Image size 2212x1659: 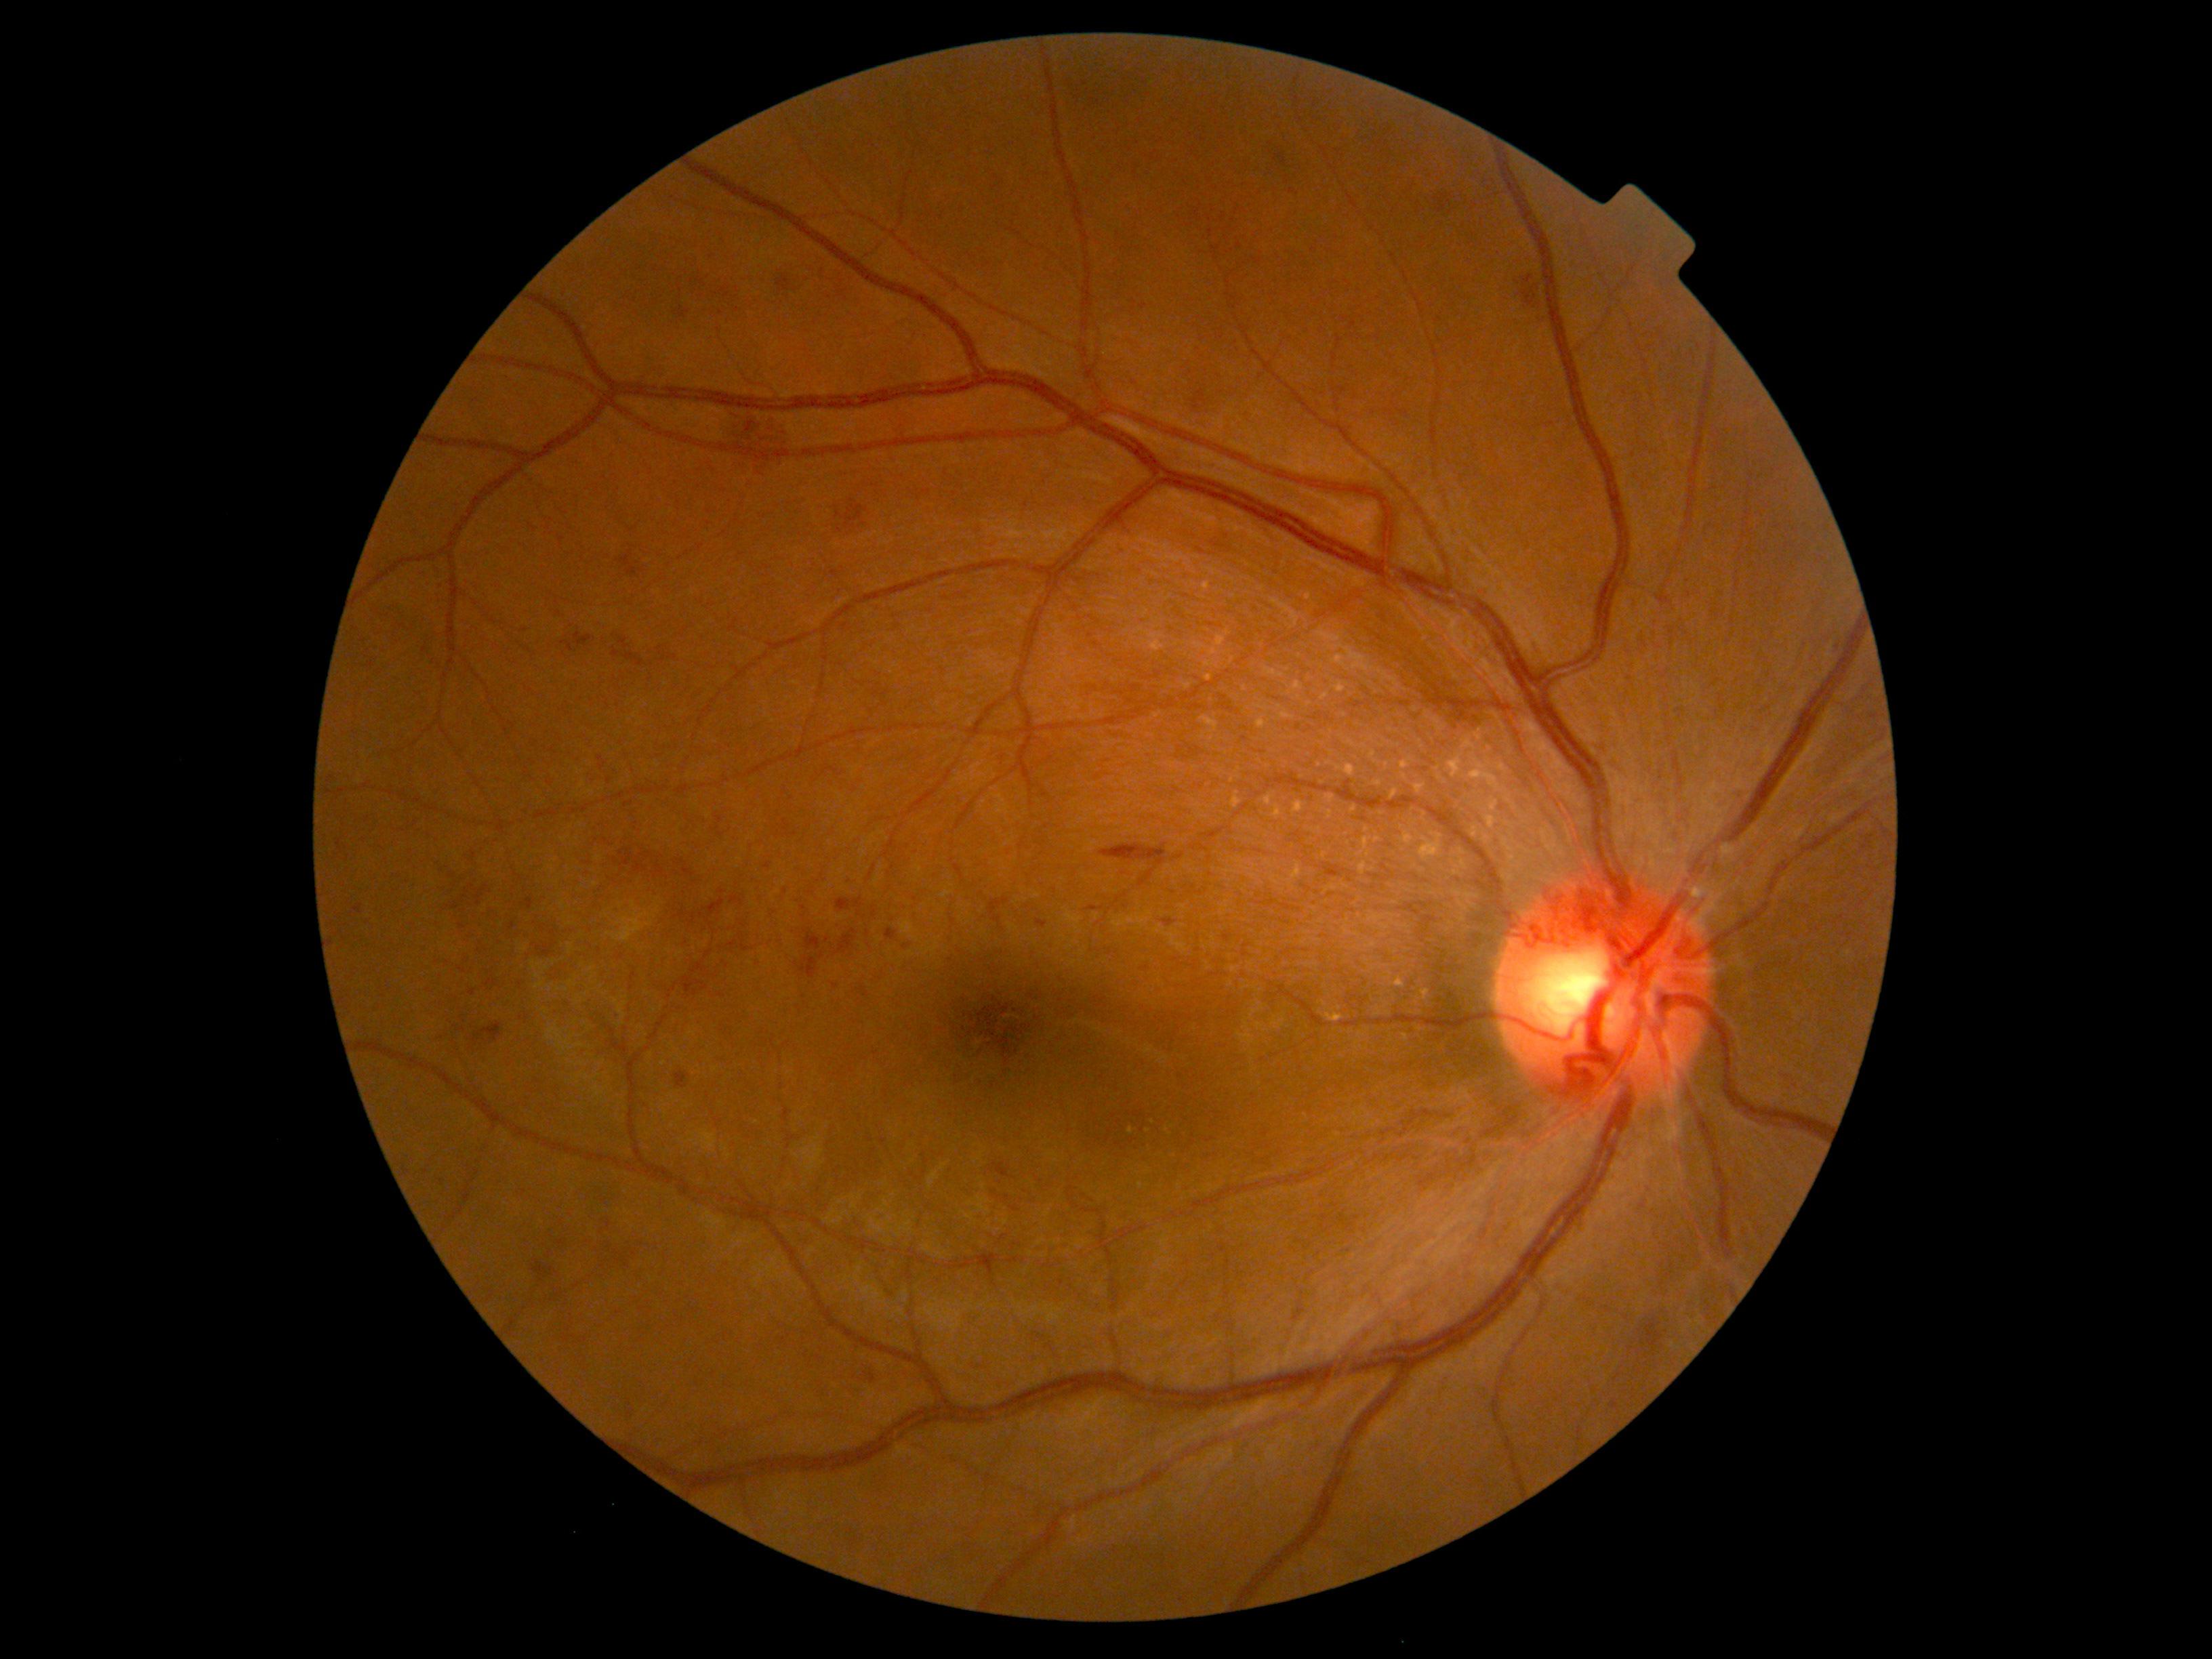 {"partial": true, "dr_grade": 2, "lesions": {"he": [[1088, 906, 1104, 913], [472, 852, 476, 860], [556, 1241, 566, 1245], [890, 424, 909, 443], [668, 655, 677, 661], [636, 357, 669, 384], [617, 552, 639, 577], [562, 642, 574, 653], [864, 1371, 876, 1383], [624, 653, 643, 666], [672, 307, 695, 321], [1196, 547, 1206, 556], [1225, 933, 1233, 941]], "he_small": [[727, 965], [643, 571], [906, 947], [464, 1030]]}}